45° FOV, CFP, image size 2346x1568: 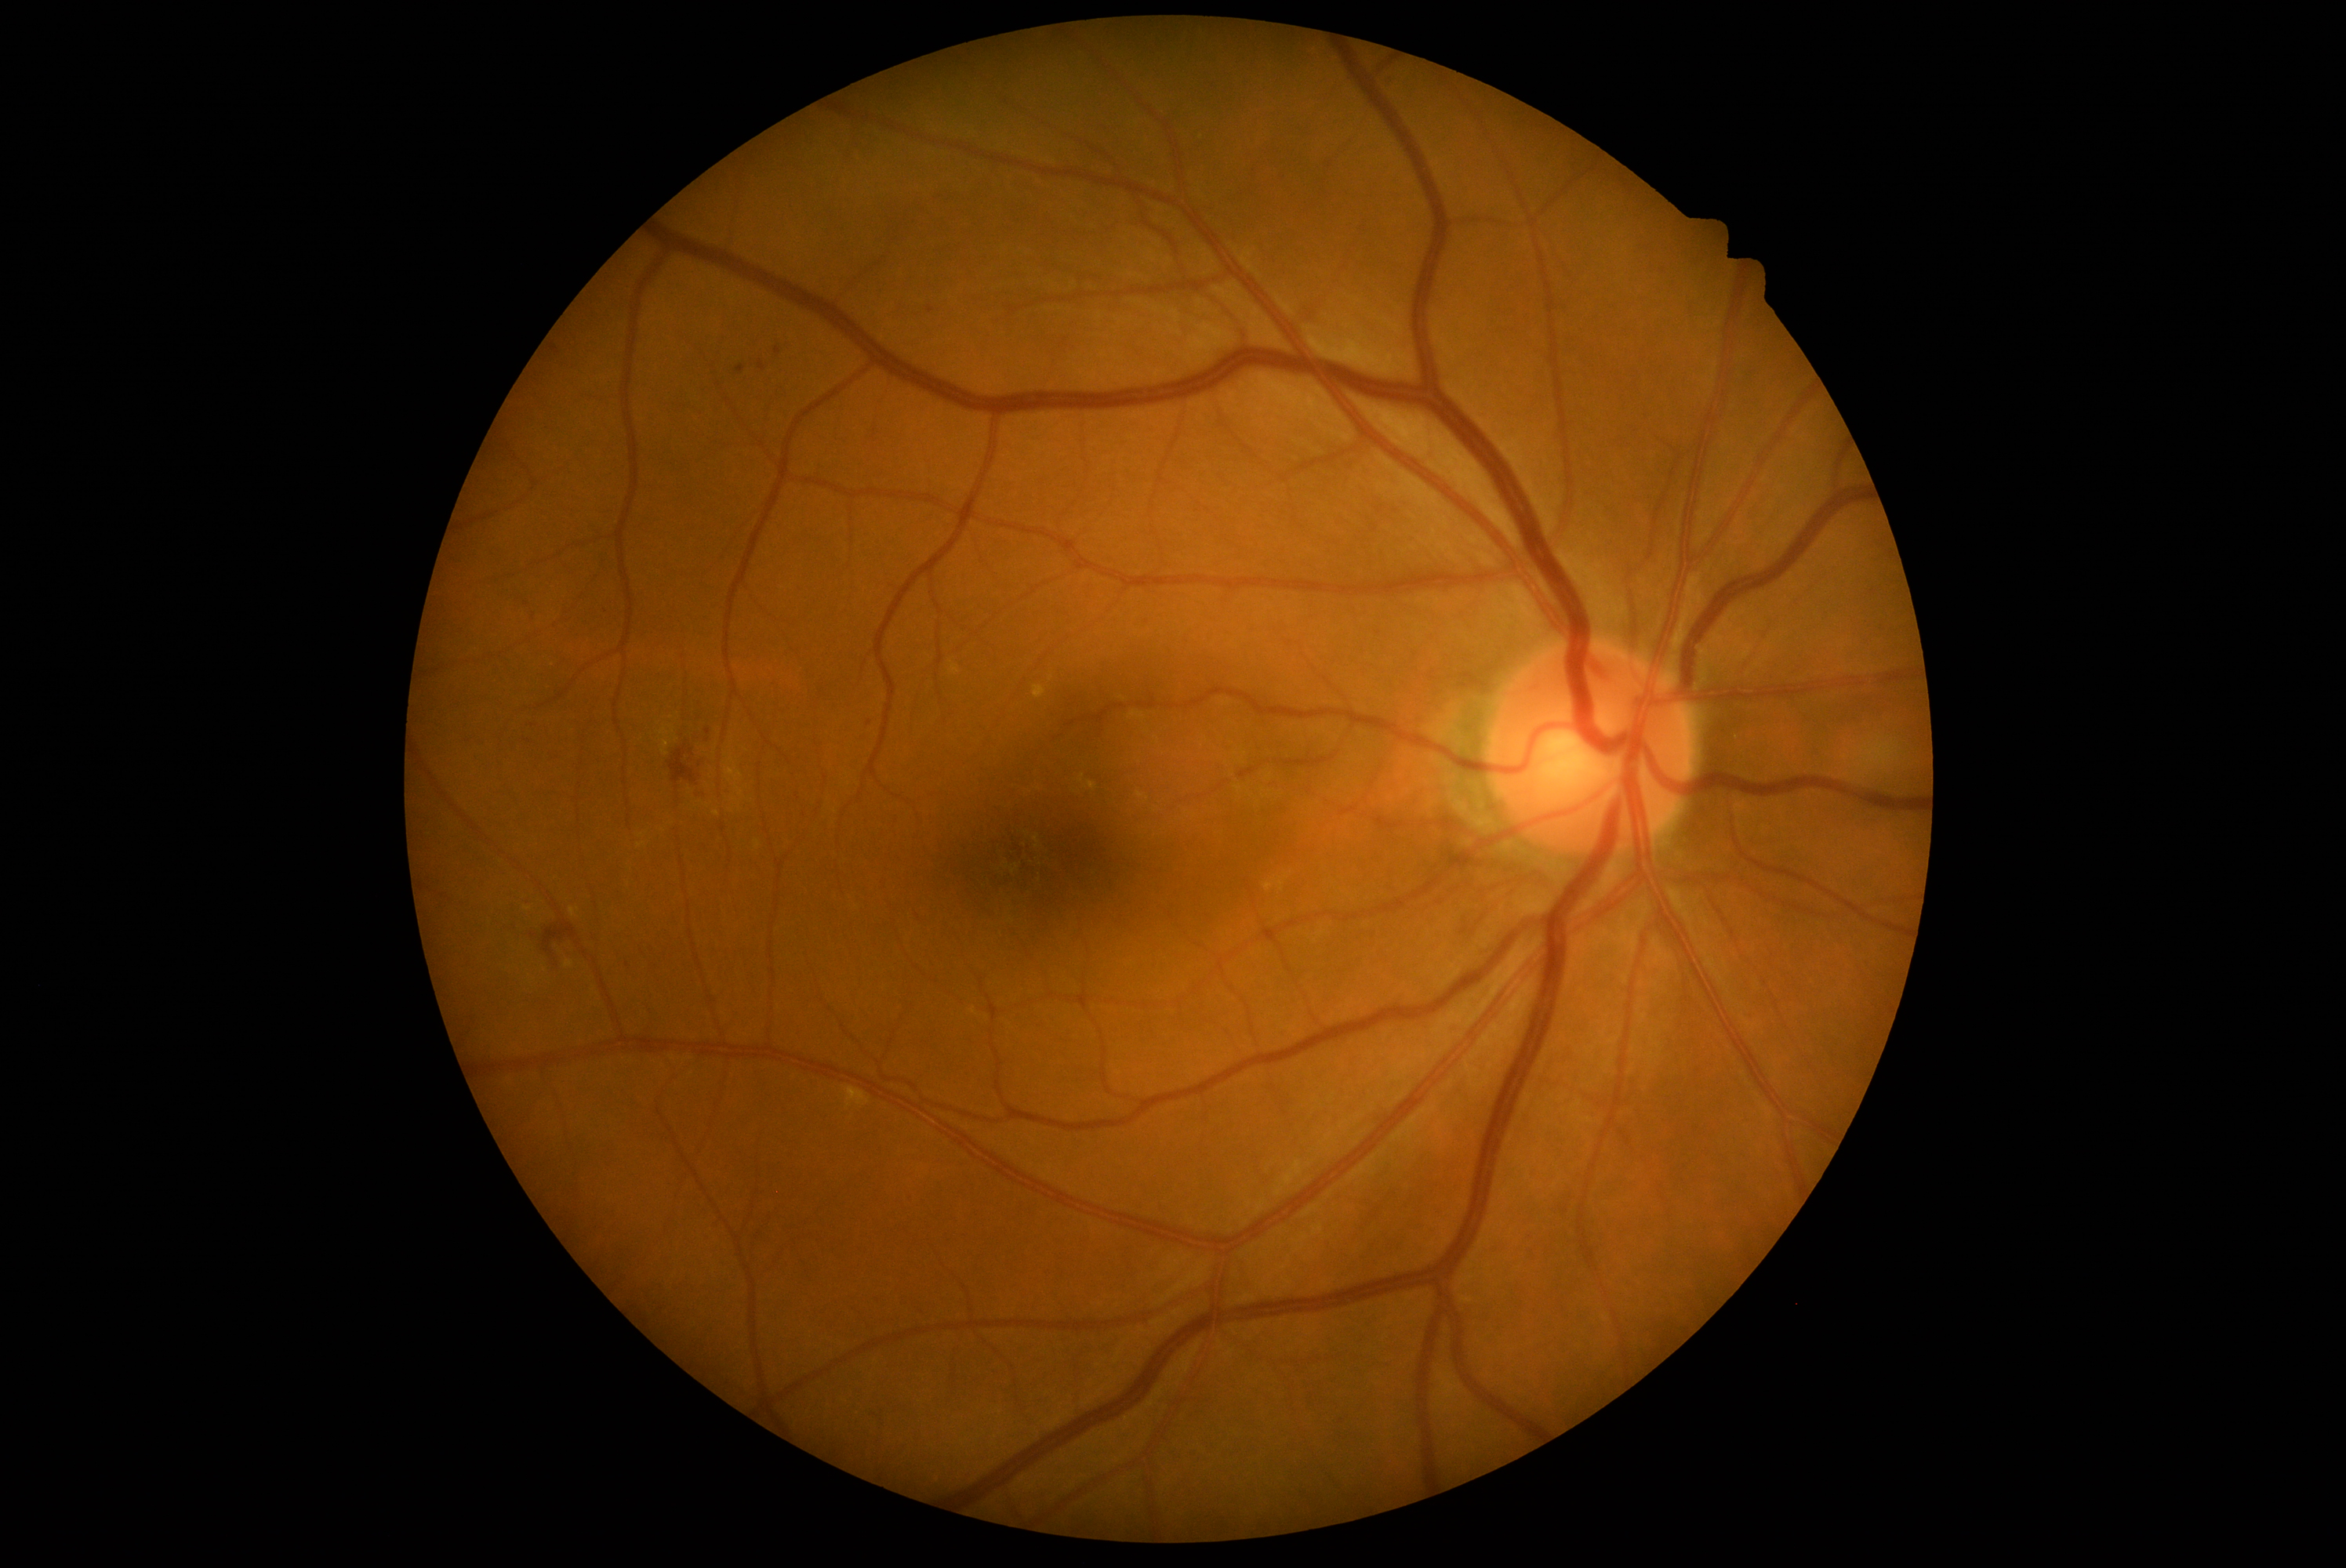

DR stage is grade 2 (moderate NPDR)
MAs: left=736, top=365, right=746, bottom=374 | left=697, top=791, right=706, bottom=799 | left=774, top=347, right=782, bottom=357 | left=758, top=360, right=766, bottom=372
Smaller MAs around (x=931, y=310) | (x=869, y=724) | (x=607, y=611) | (x=708, y=732)
EXs: left=661, top=728, right=669, bottom=736 | left=1089, top=782, right=1097, bottom=791 | left=570, top=907, right=579, bottom=918 | left=843, top=1087, right=854, bottom=1095 | left=1265, top=884, right=1274, bottom=891 | left=1033, top=686, right=1047, bottom=700
Smaller EXs around (x=528, y=909) | (x=716, y=814)
HEs: left=1379, top=73, right=1400, bottom=89 | left=692, top=791, right=705, bottom=797 | left=670, top=747, right=699, bottom=789 | left=543, top=921, right=578, bottom=957
SEs: none